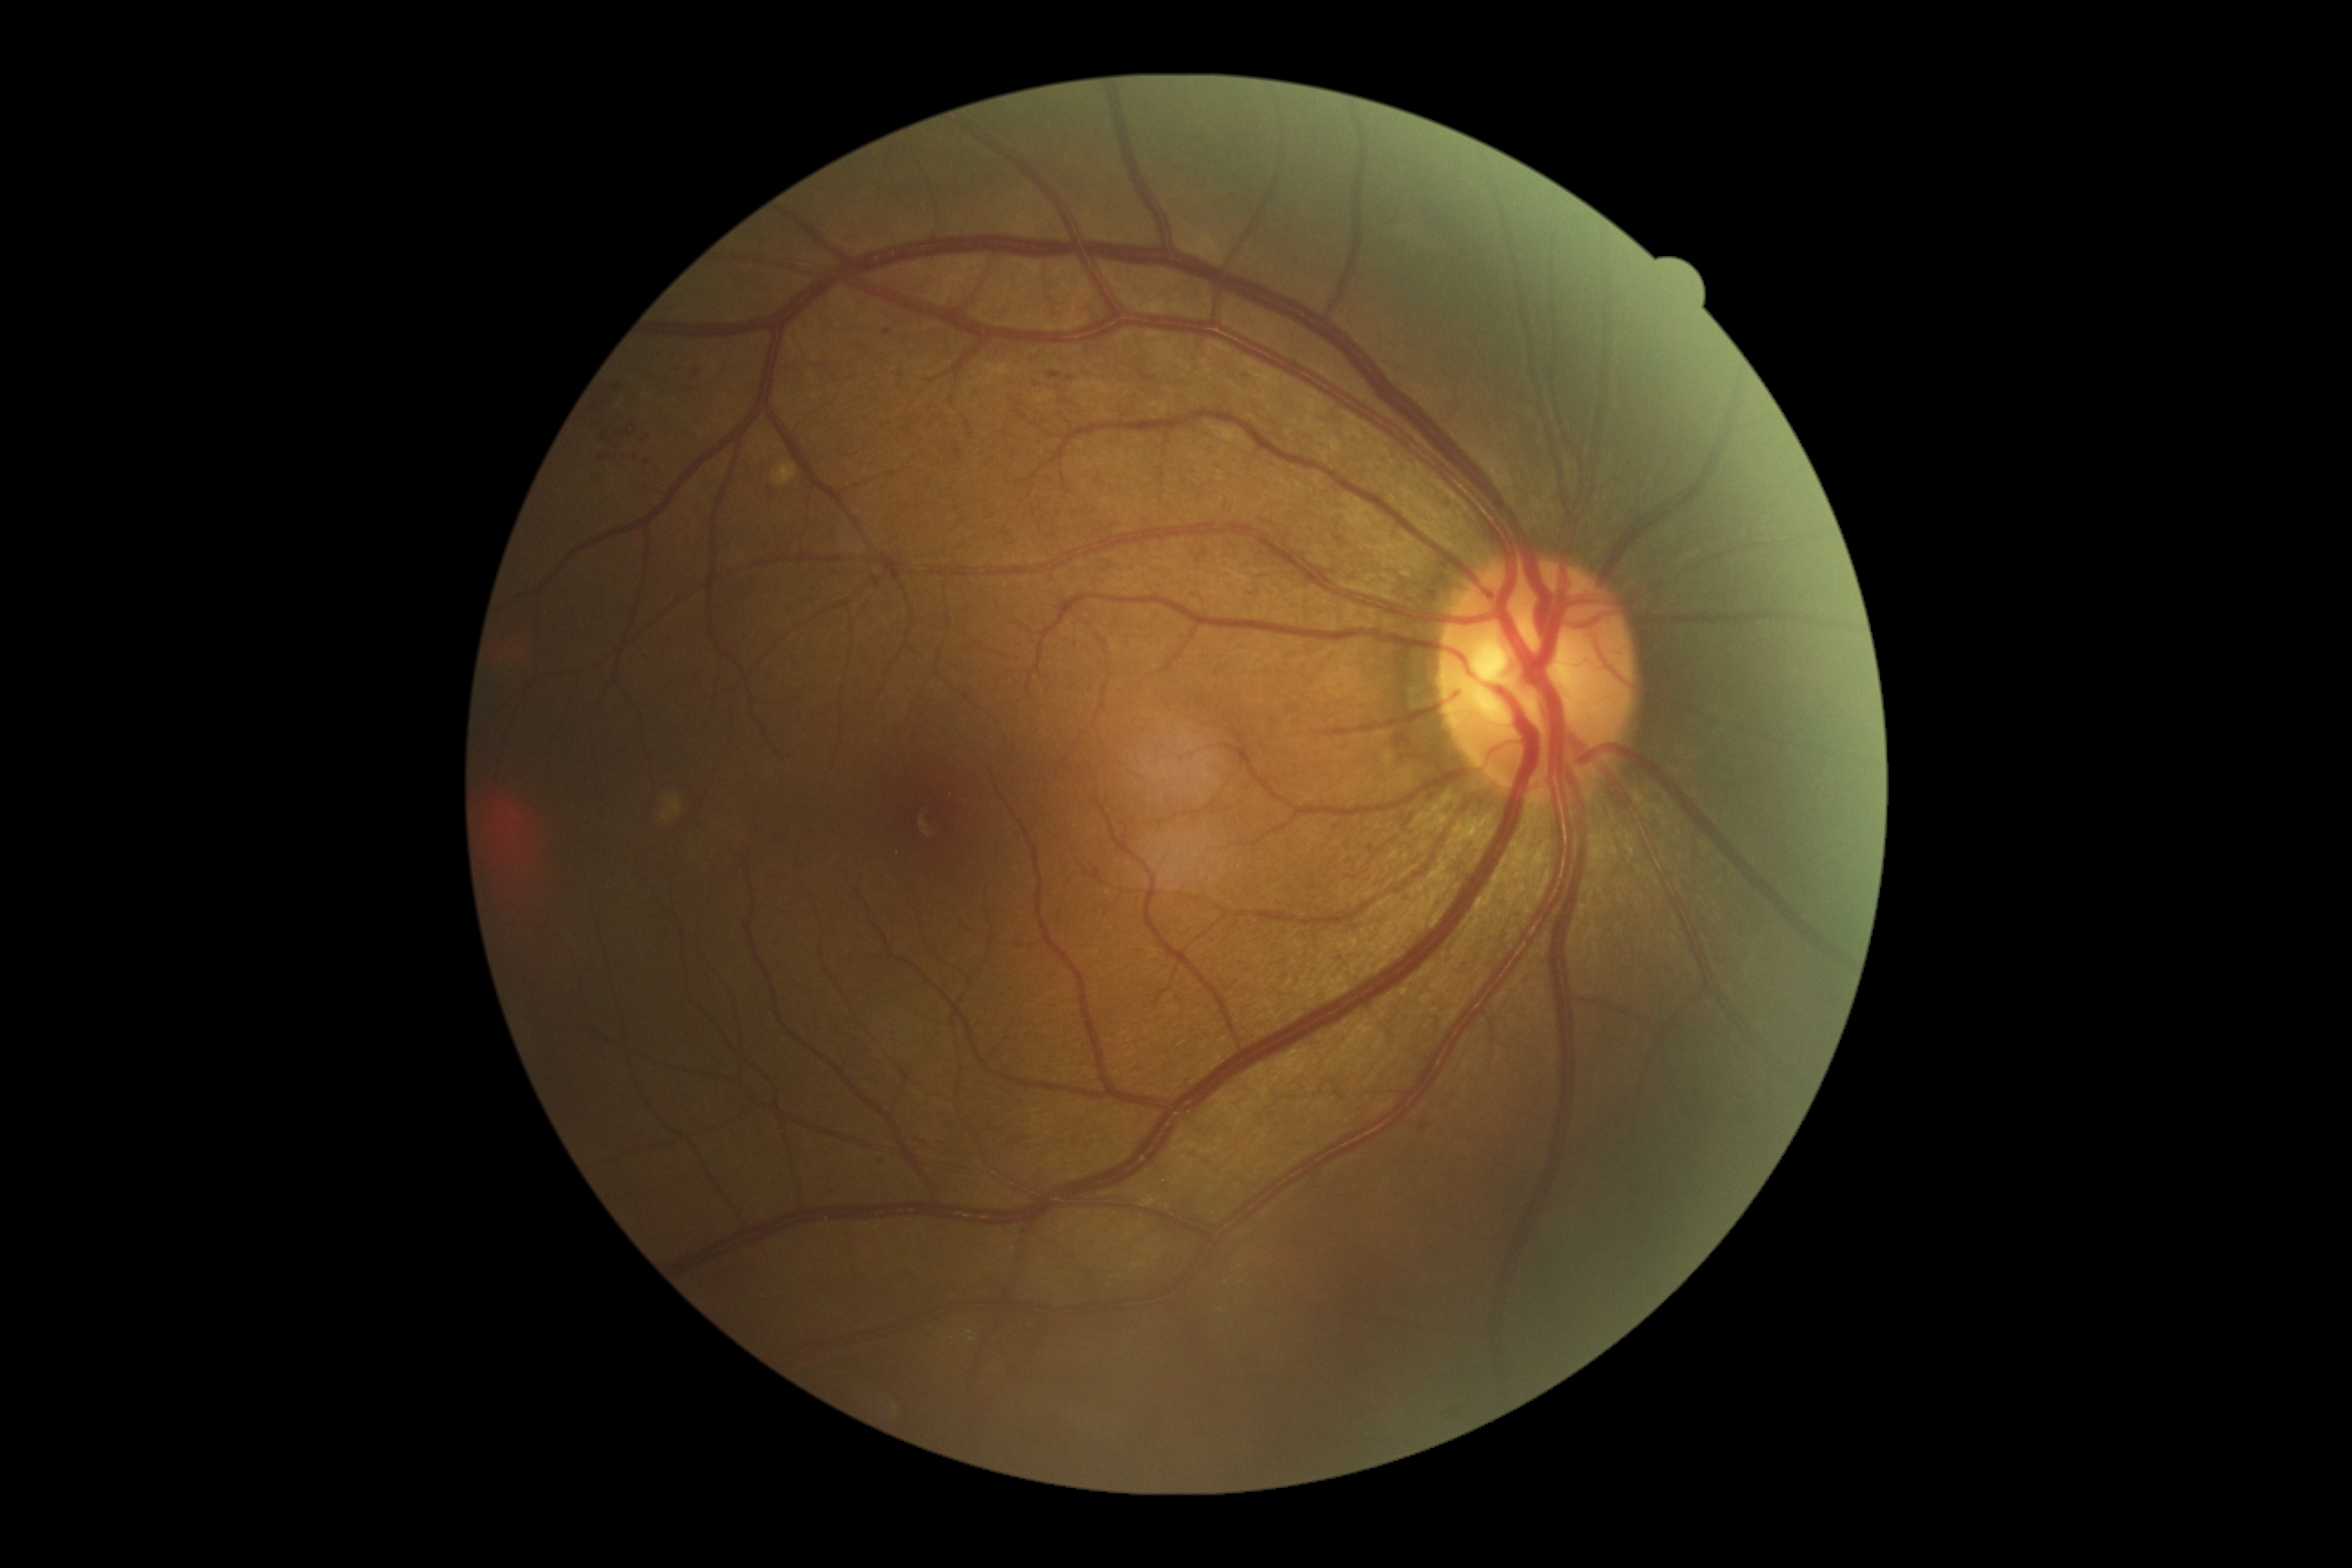 {"dr_grade": "moderate NPDR (grade 2)"}